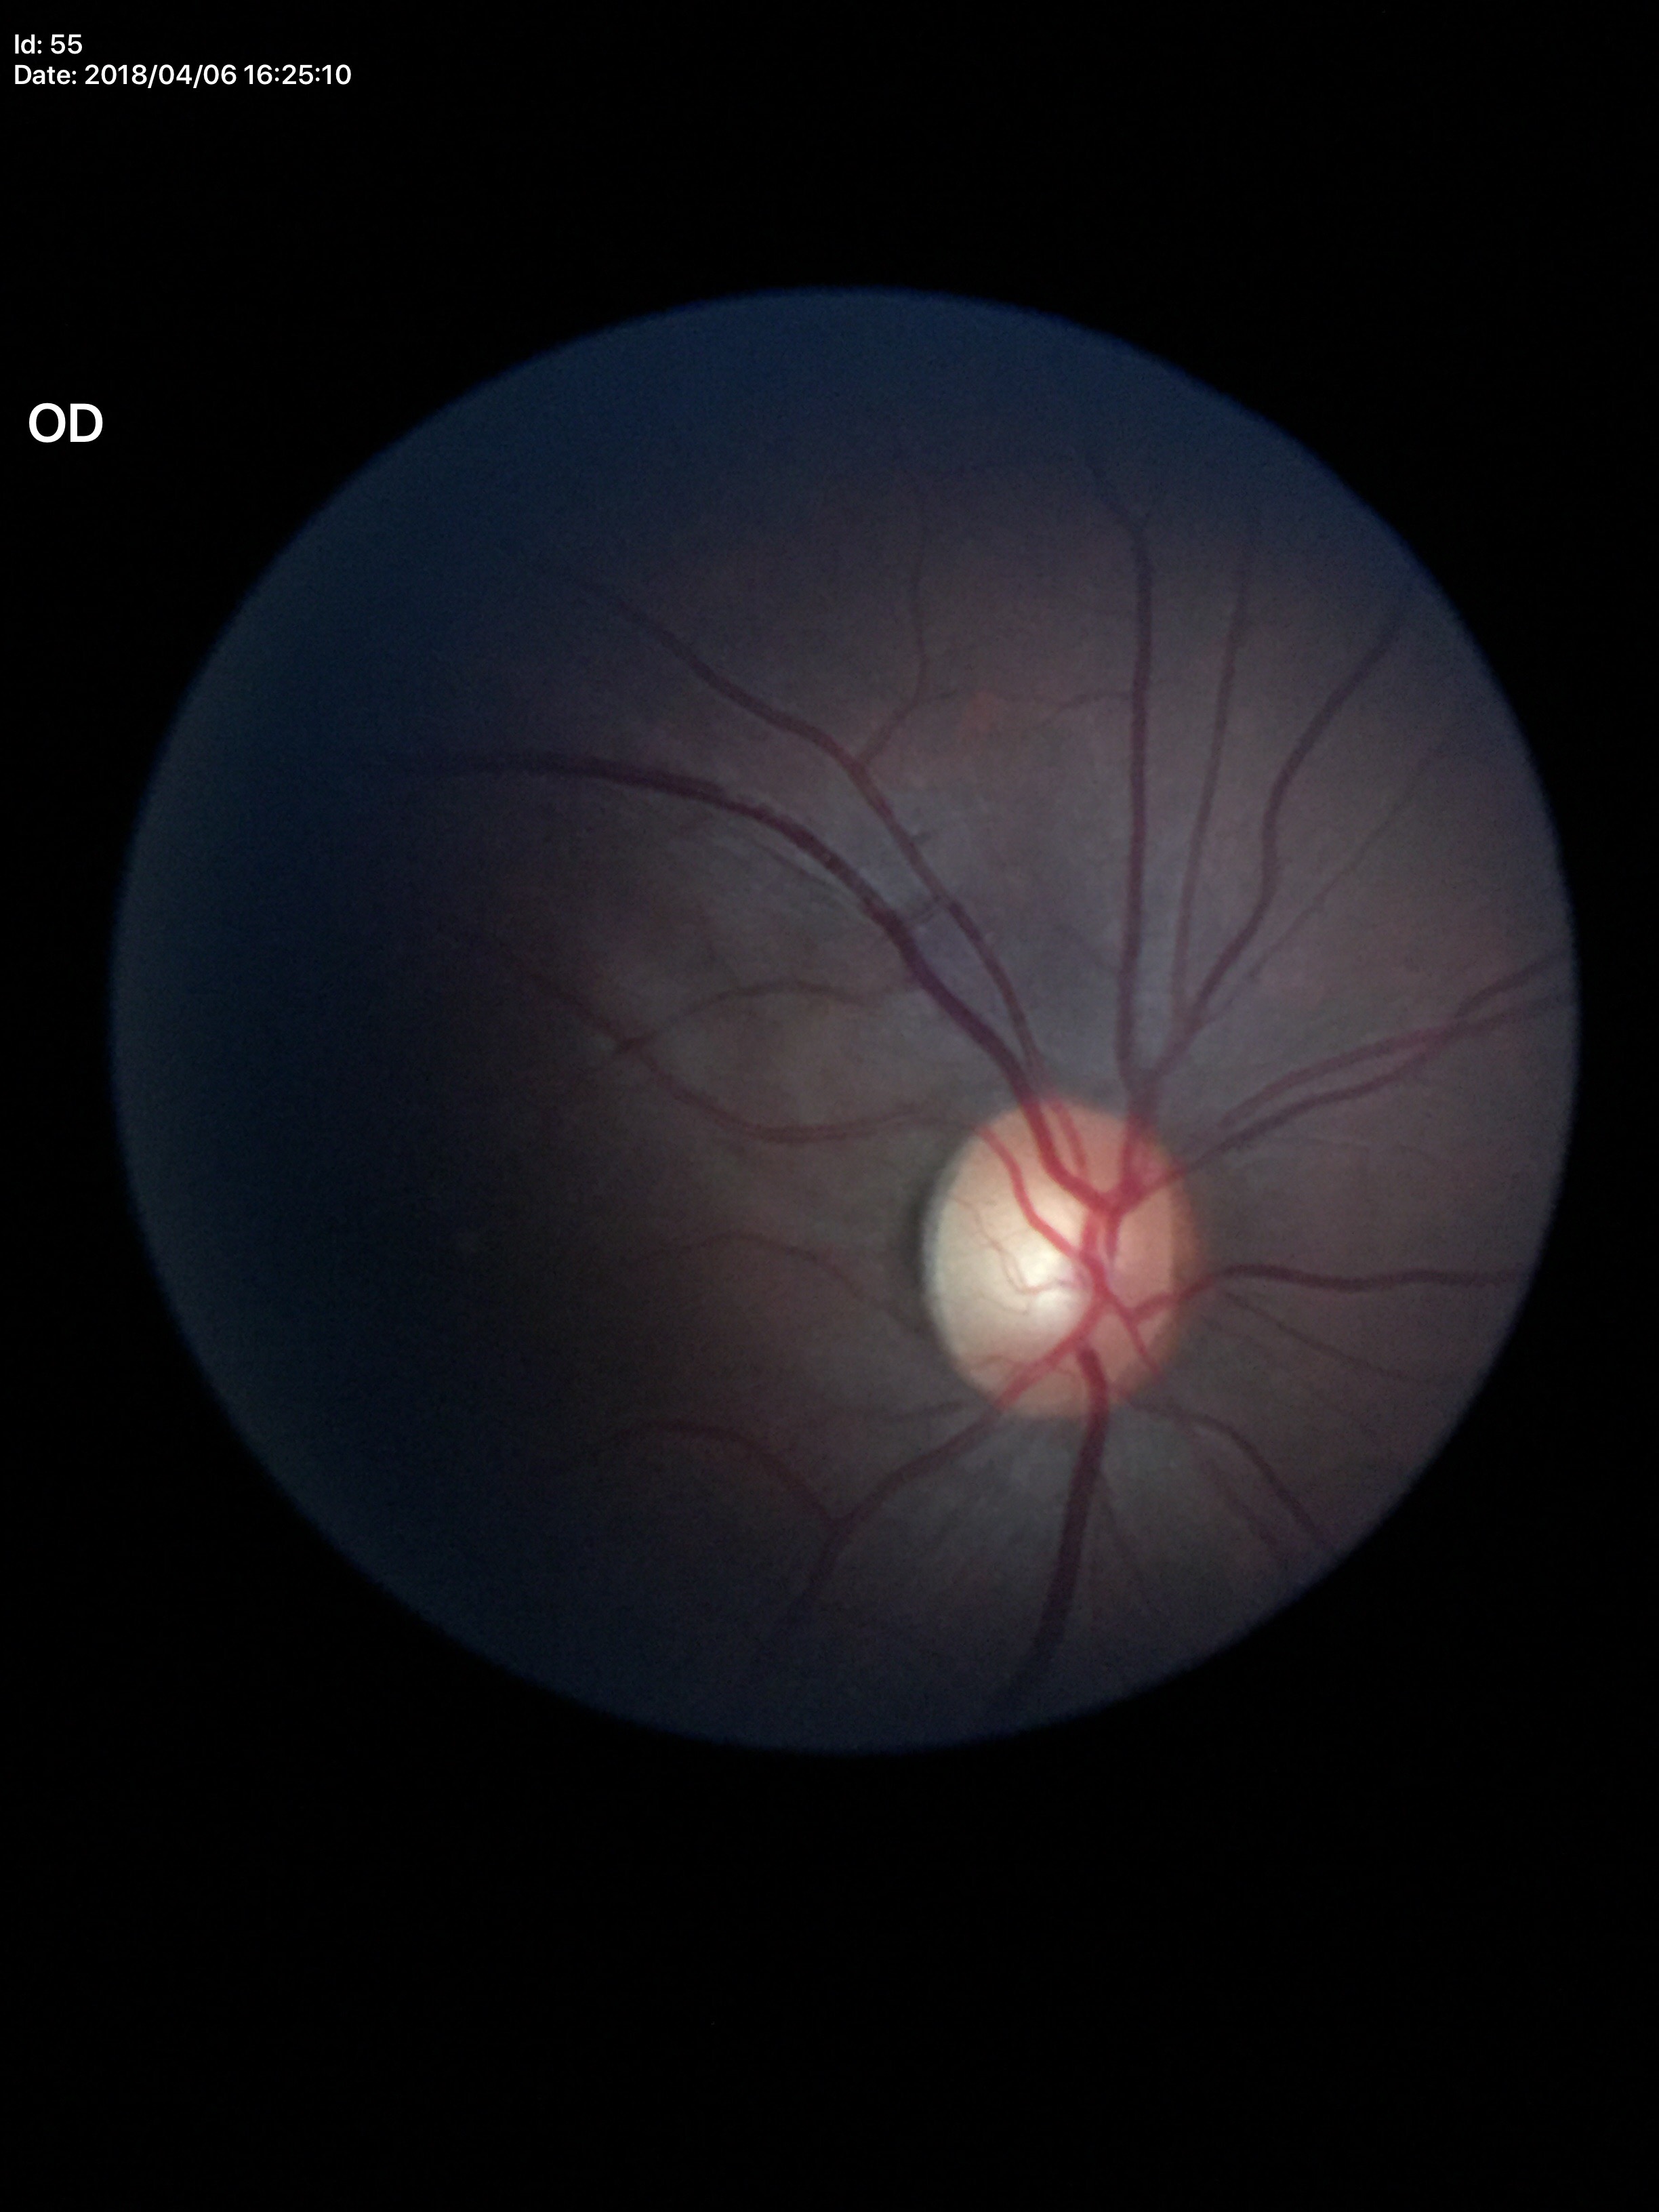

Glaucoma assessment: suspect.
Vertical cup-to-disc ratio is 0.61.